NIDEK AFC-230; 848 by 848 pixels
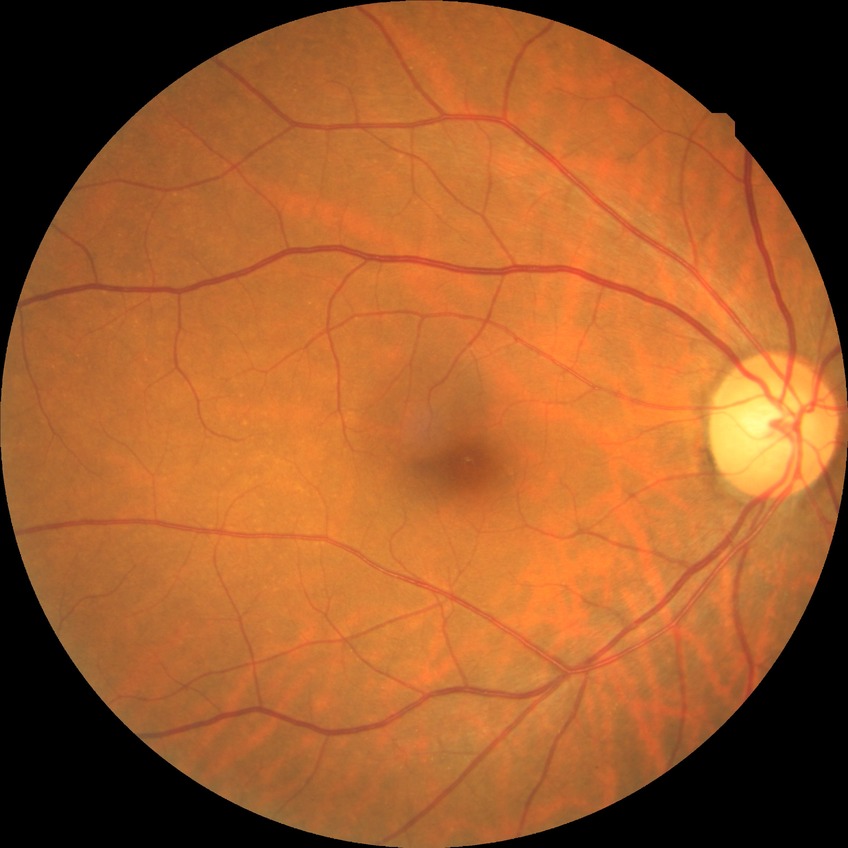
Davis grading: no diabetic retinopathy.